Davis DR grading: 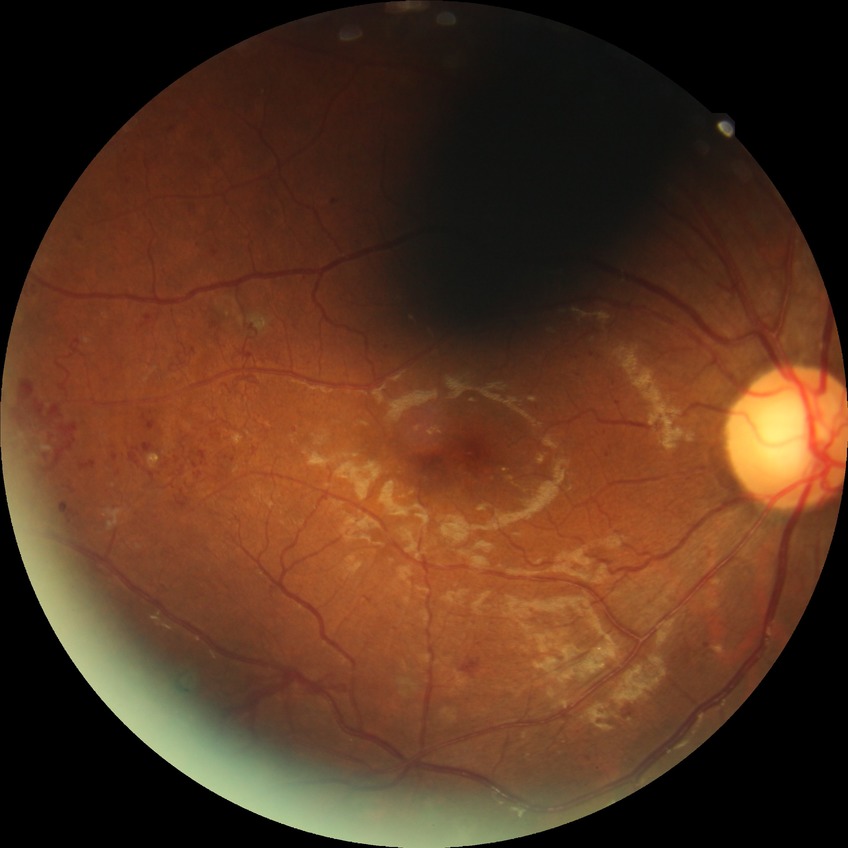 Davis grade: PDR.